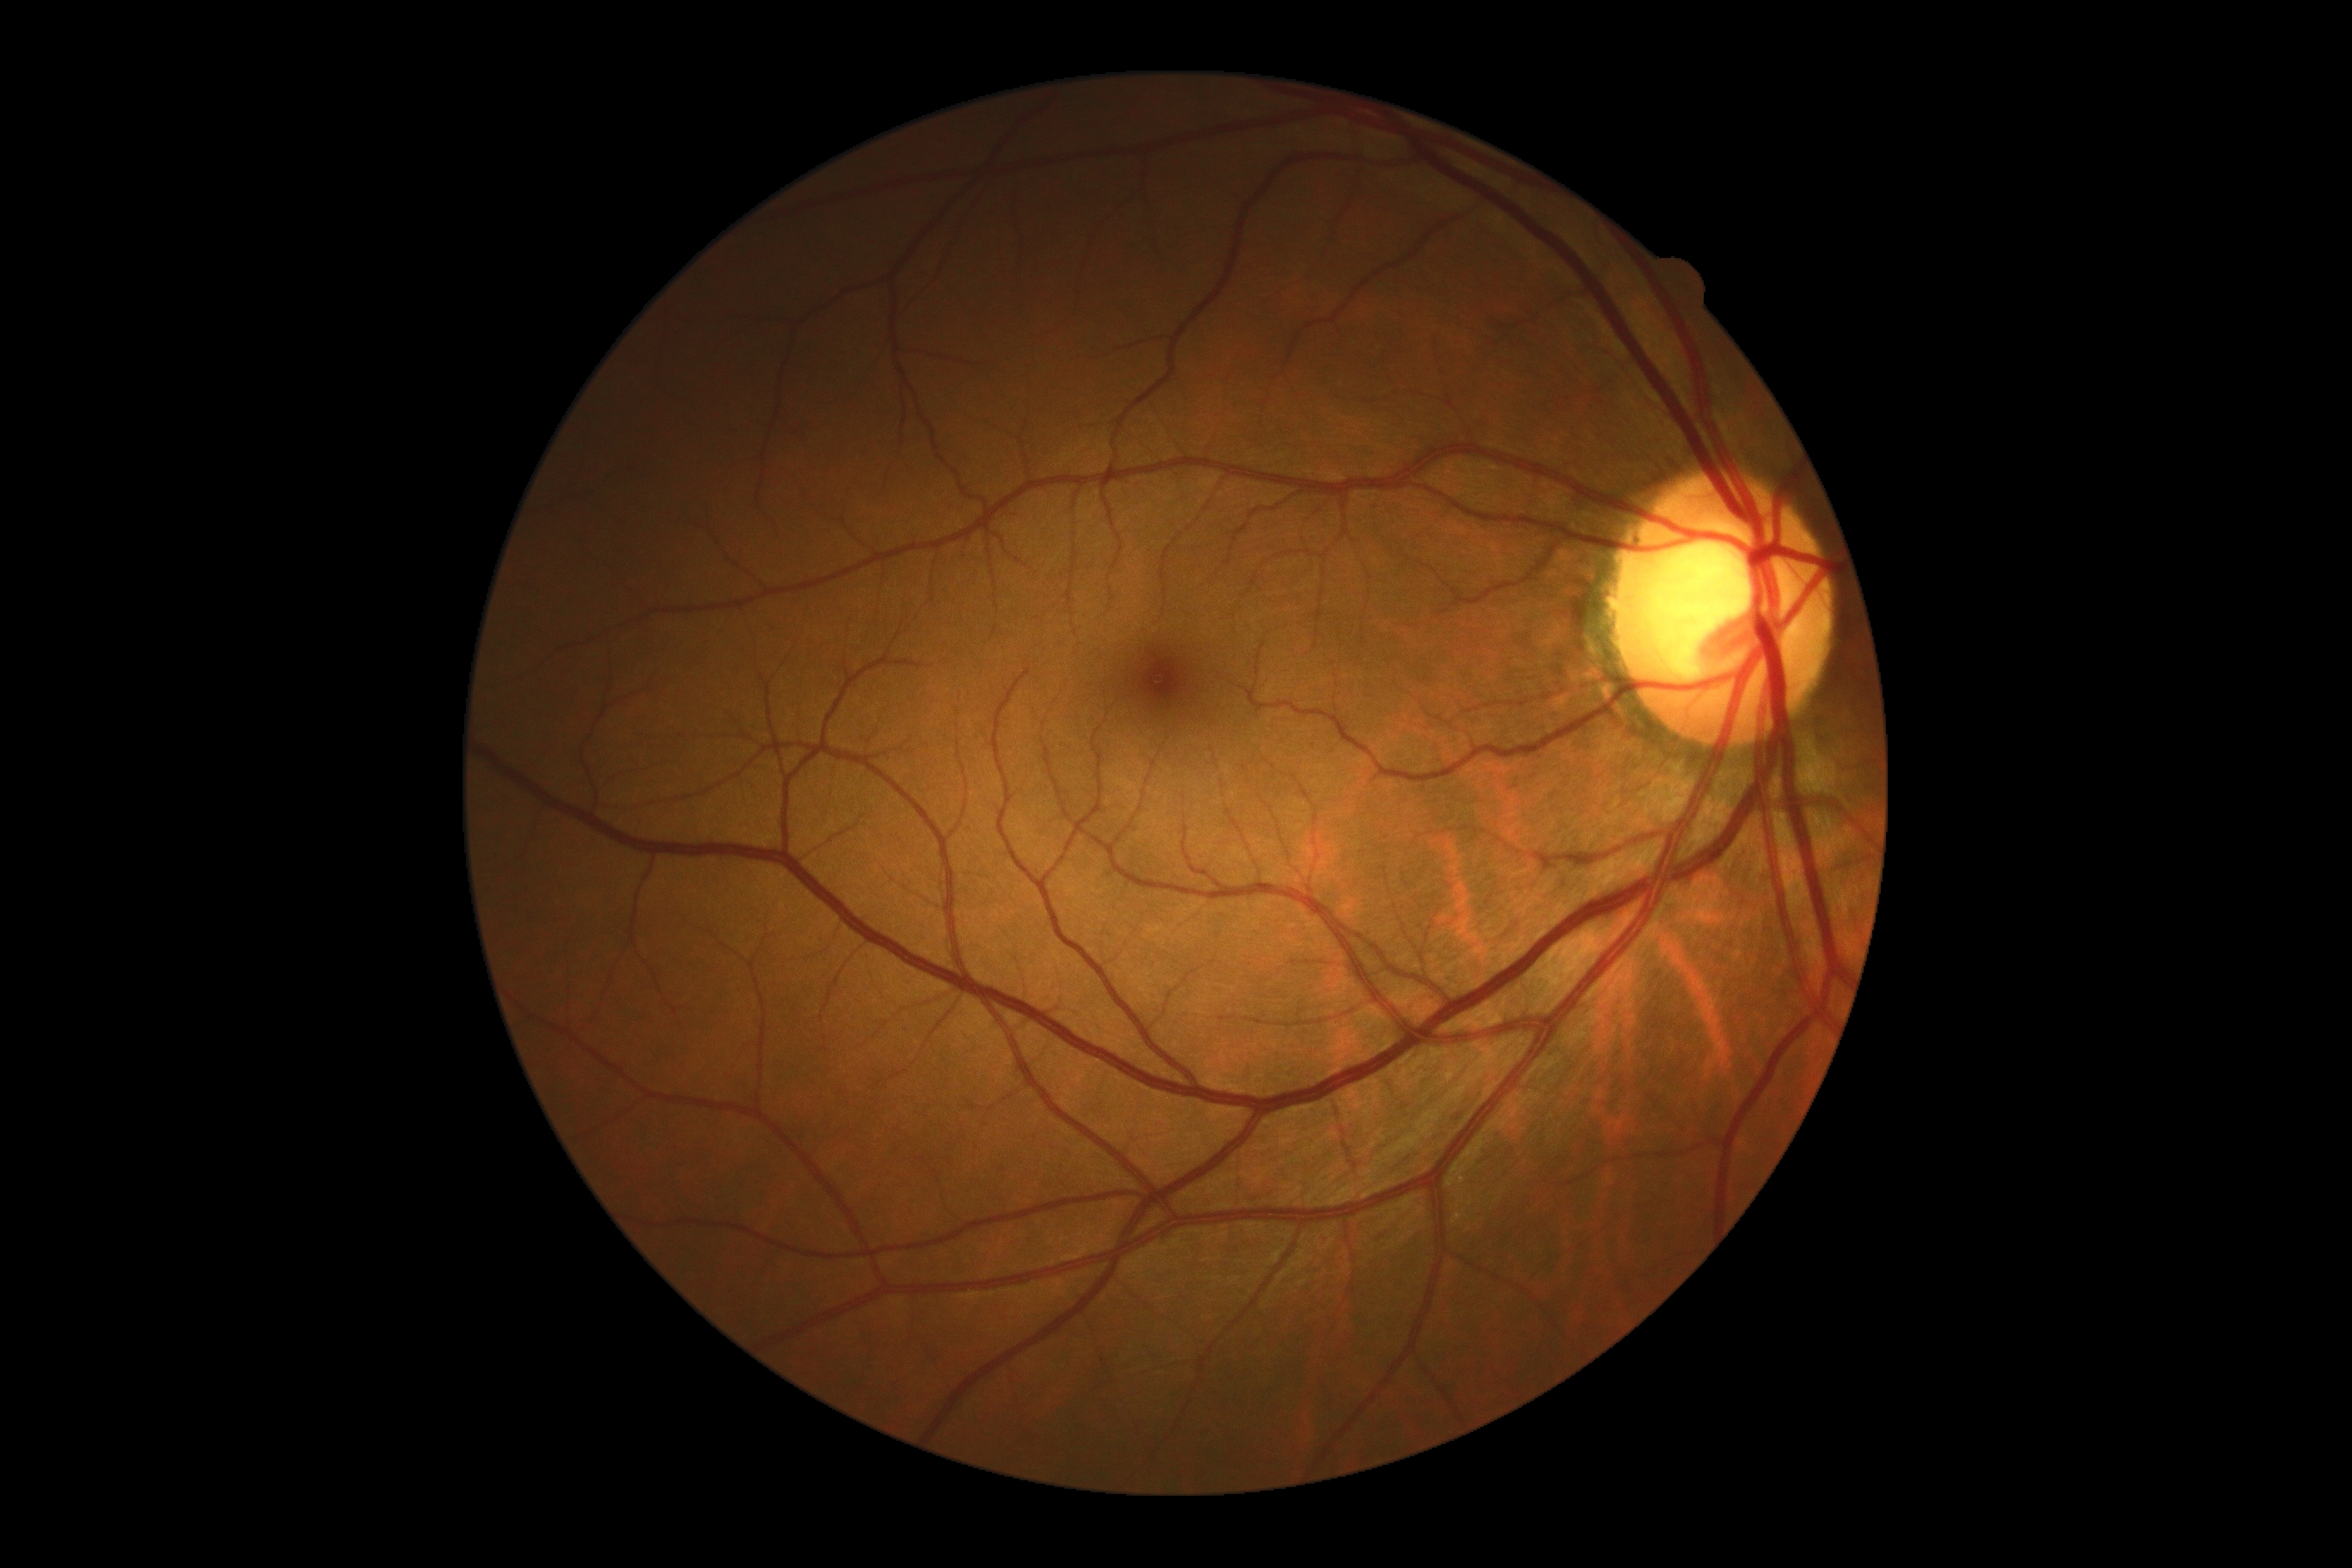
No apparent diabetic retinopathy.
Diabetic retinopathy: grade 0 (no apparent retinopathy).